Axial length 24.39 mm. Intraocular pressure 16 mmHg by Perkins applanation tonometry. Refraction: -2.5 D
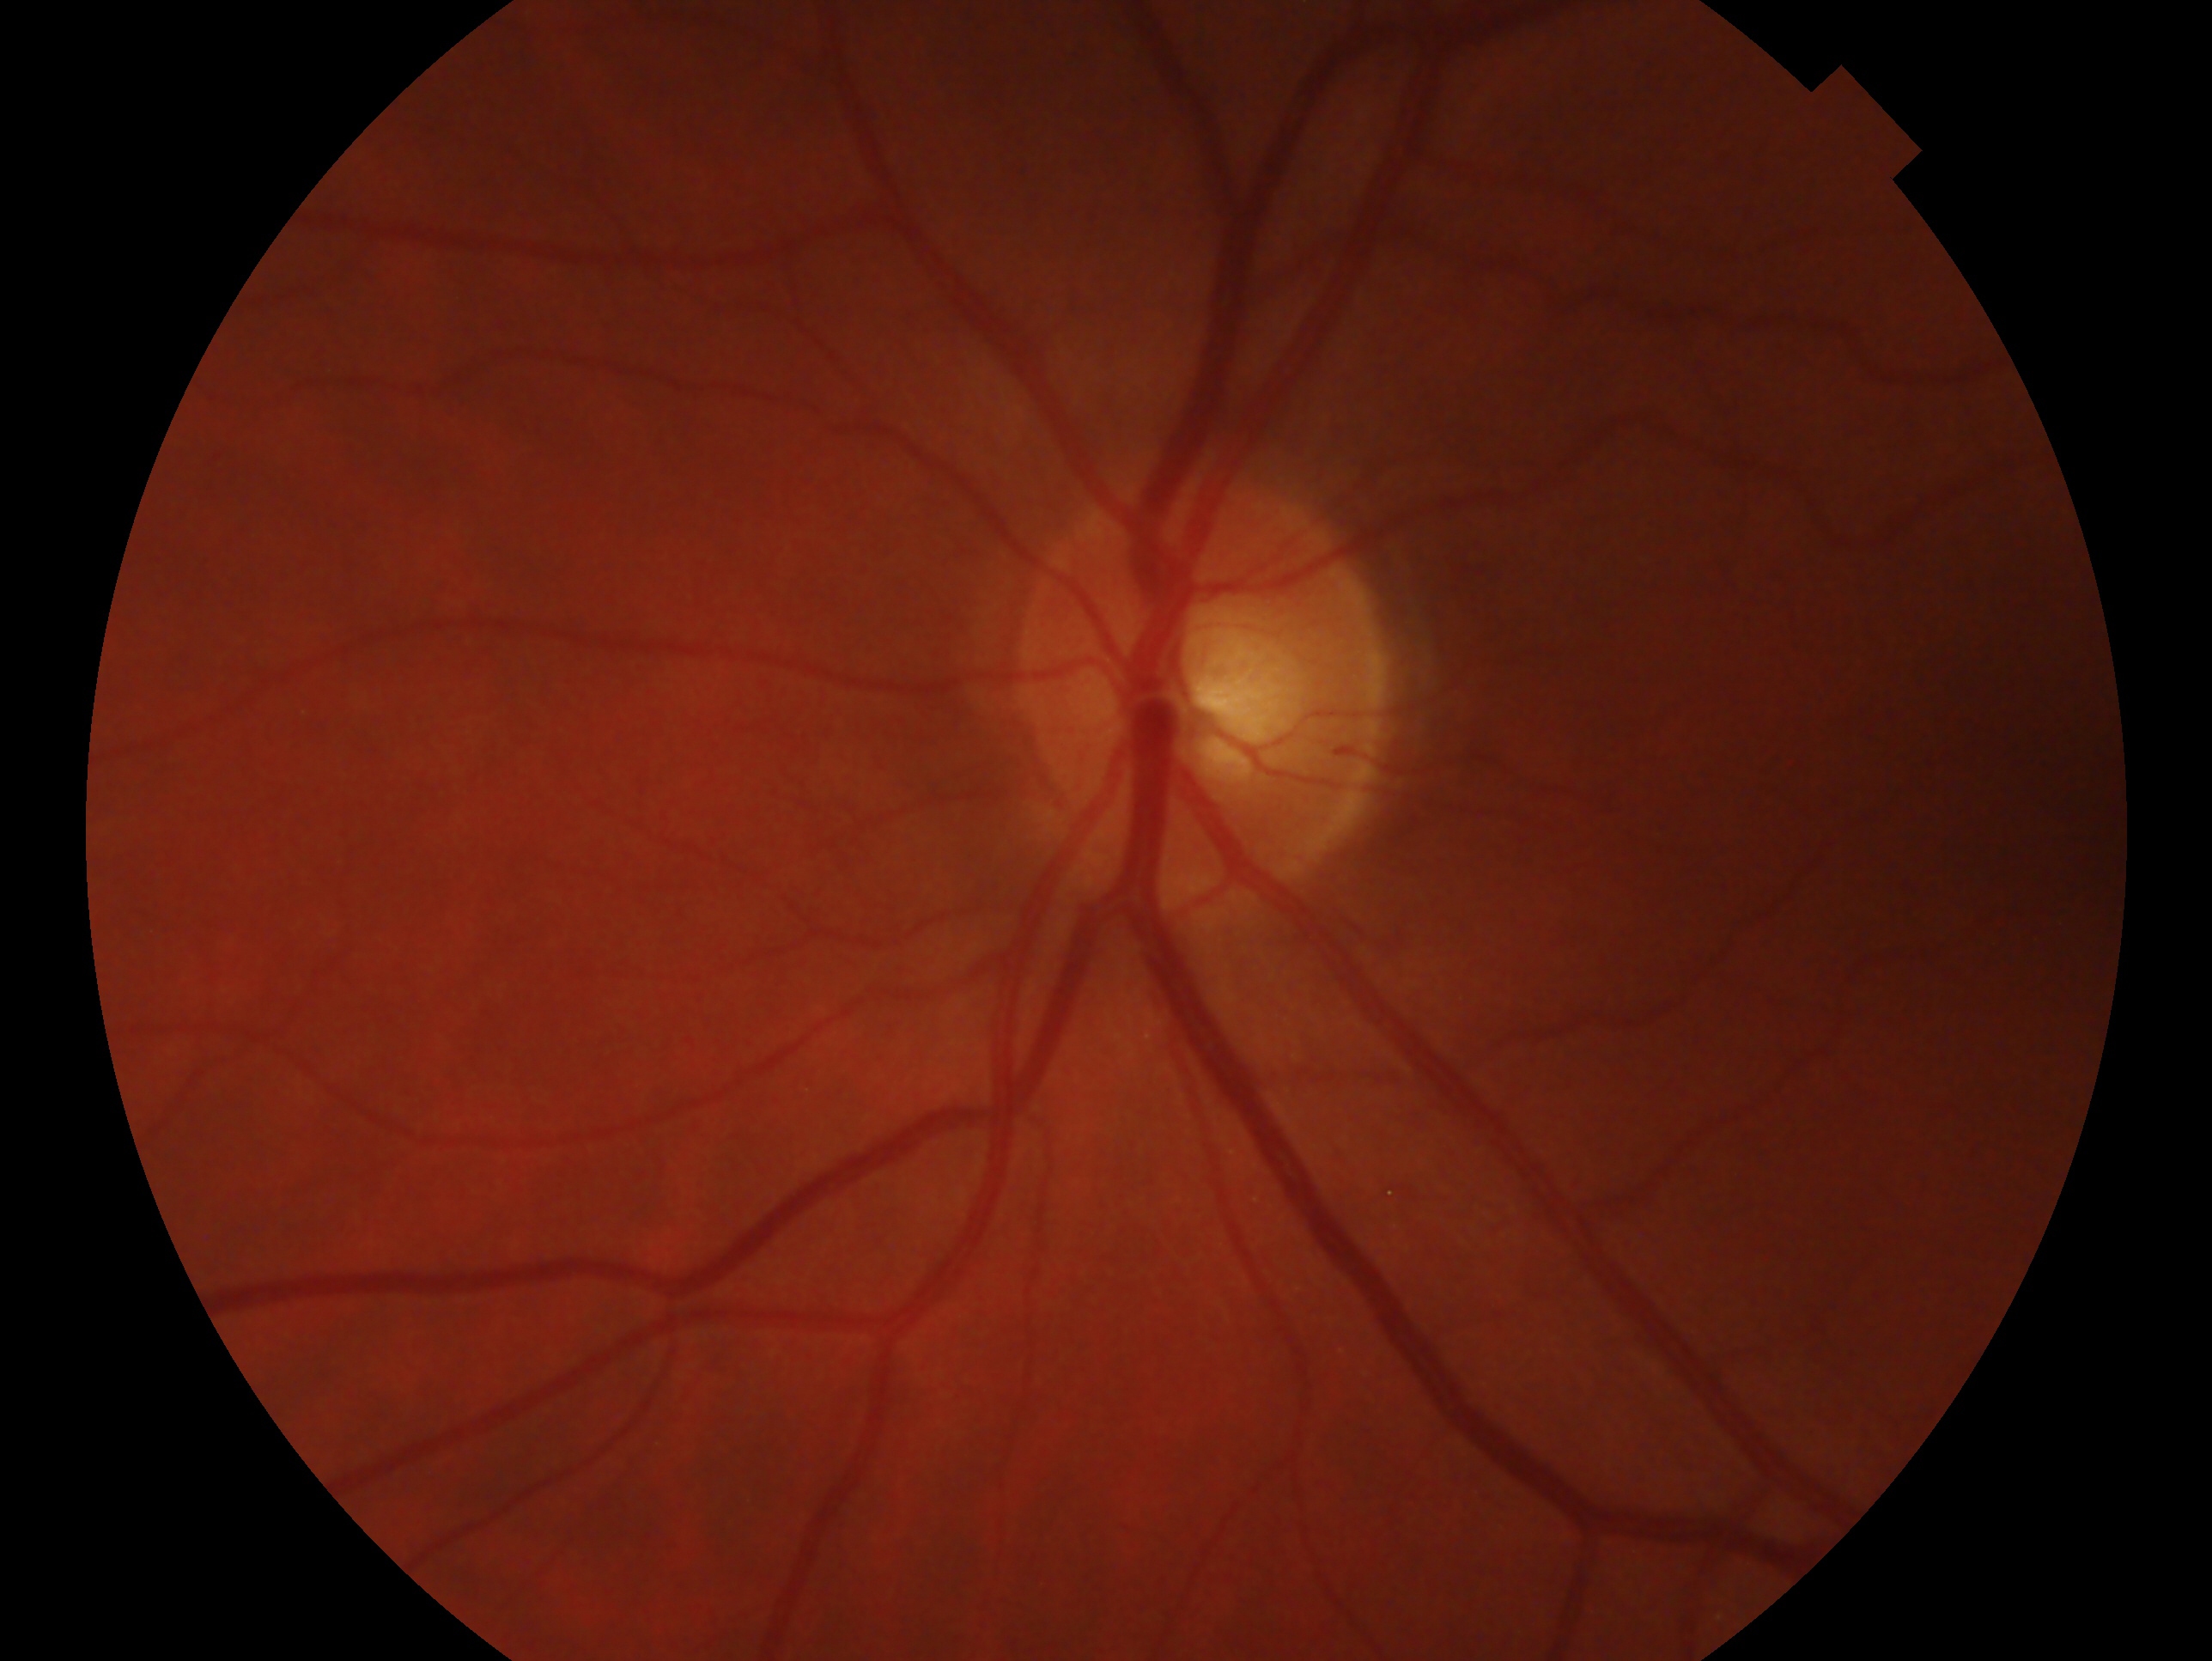 Glaucoma diagnosis: suspected glaucoma — risk factors or equivocal findings for glaucoma without a confirmed diagnosis.
Eye: oculus sinister.